Wide-field fundus photograph from neonatal ROP screening
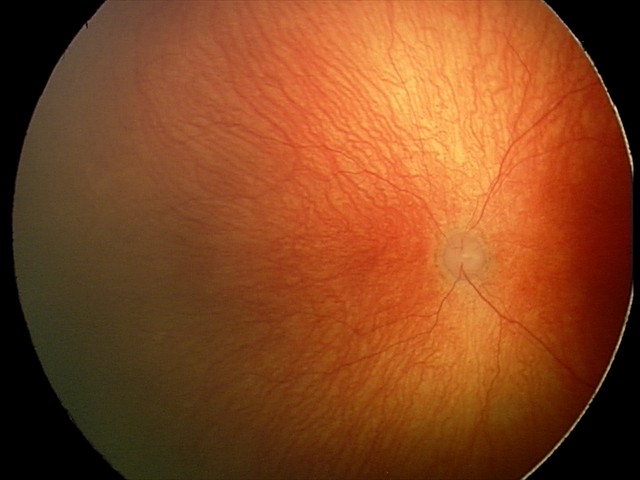

Assessment: aggressive retinopathy of prematurity.